2212x1659px — 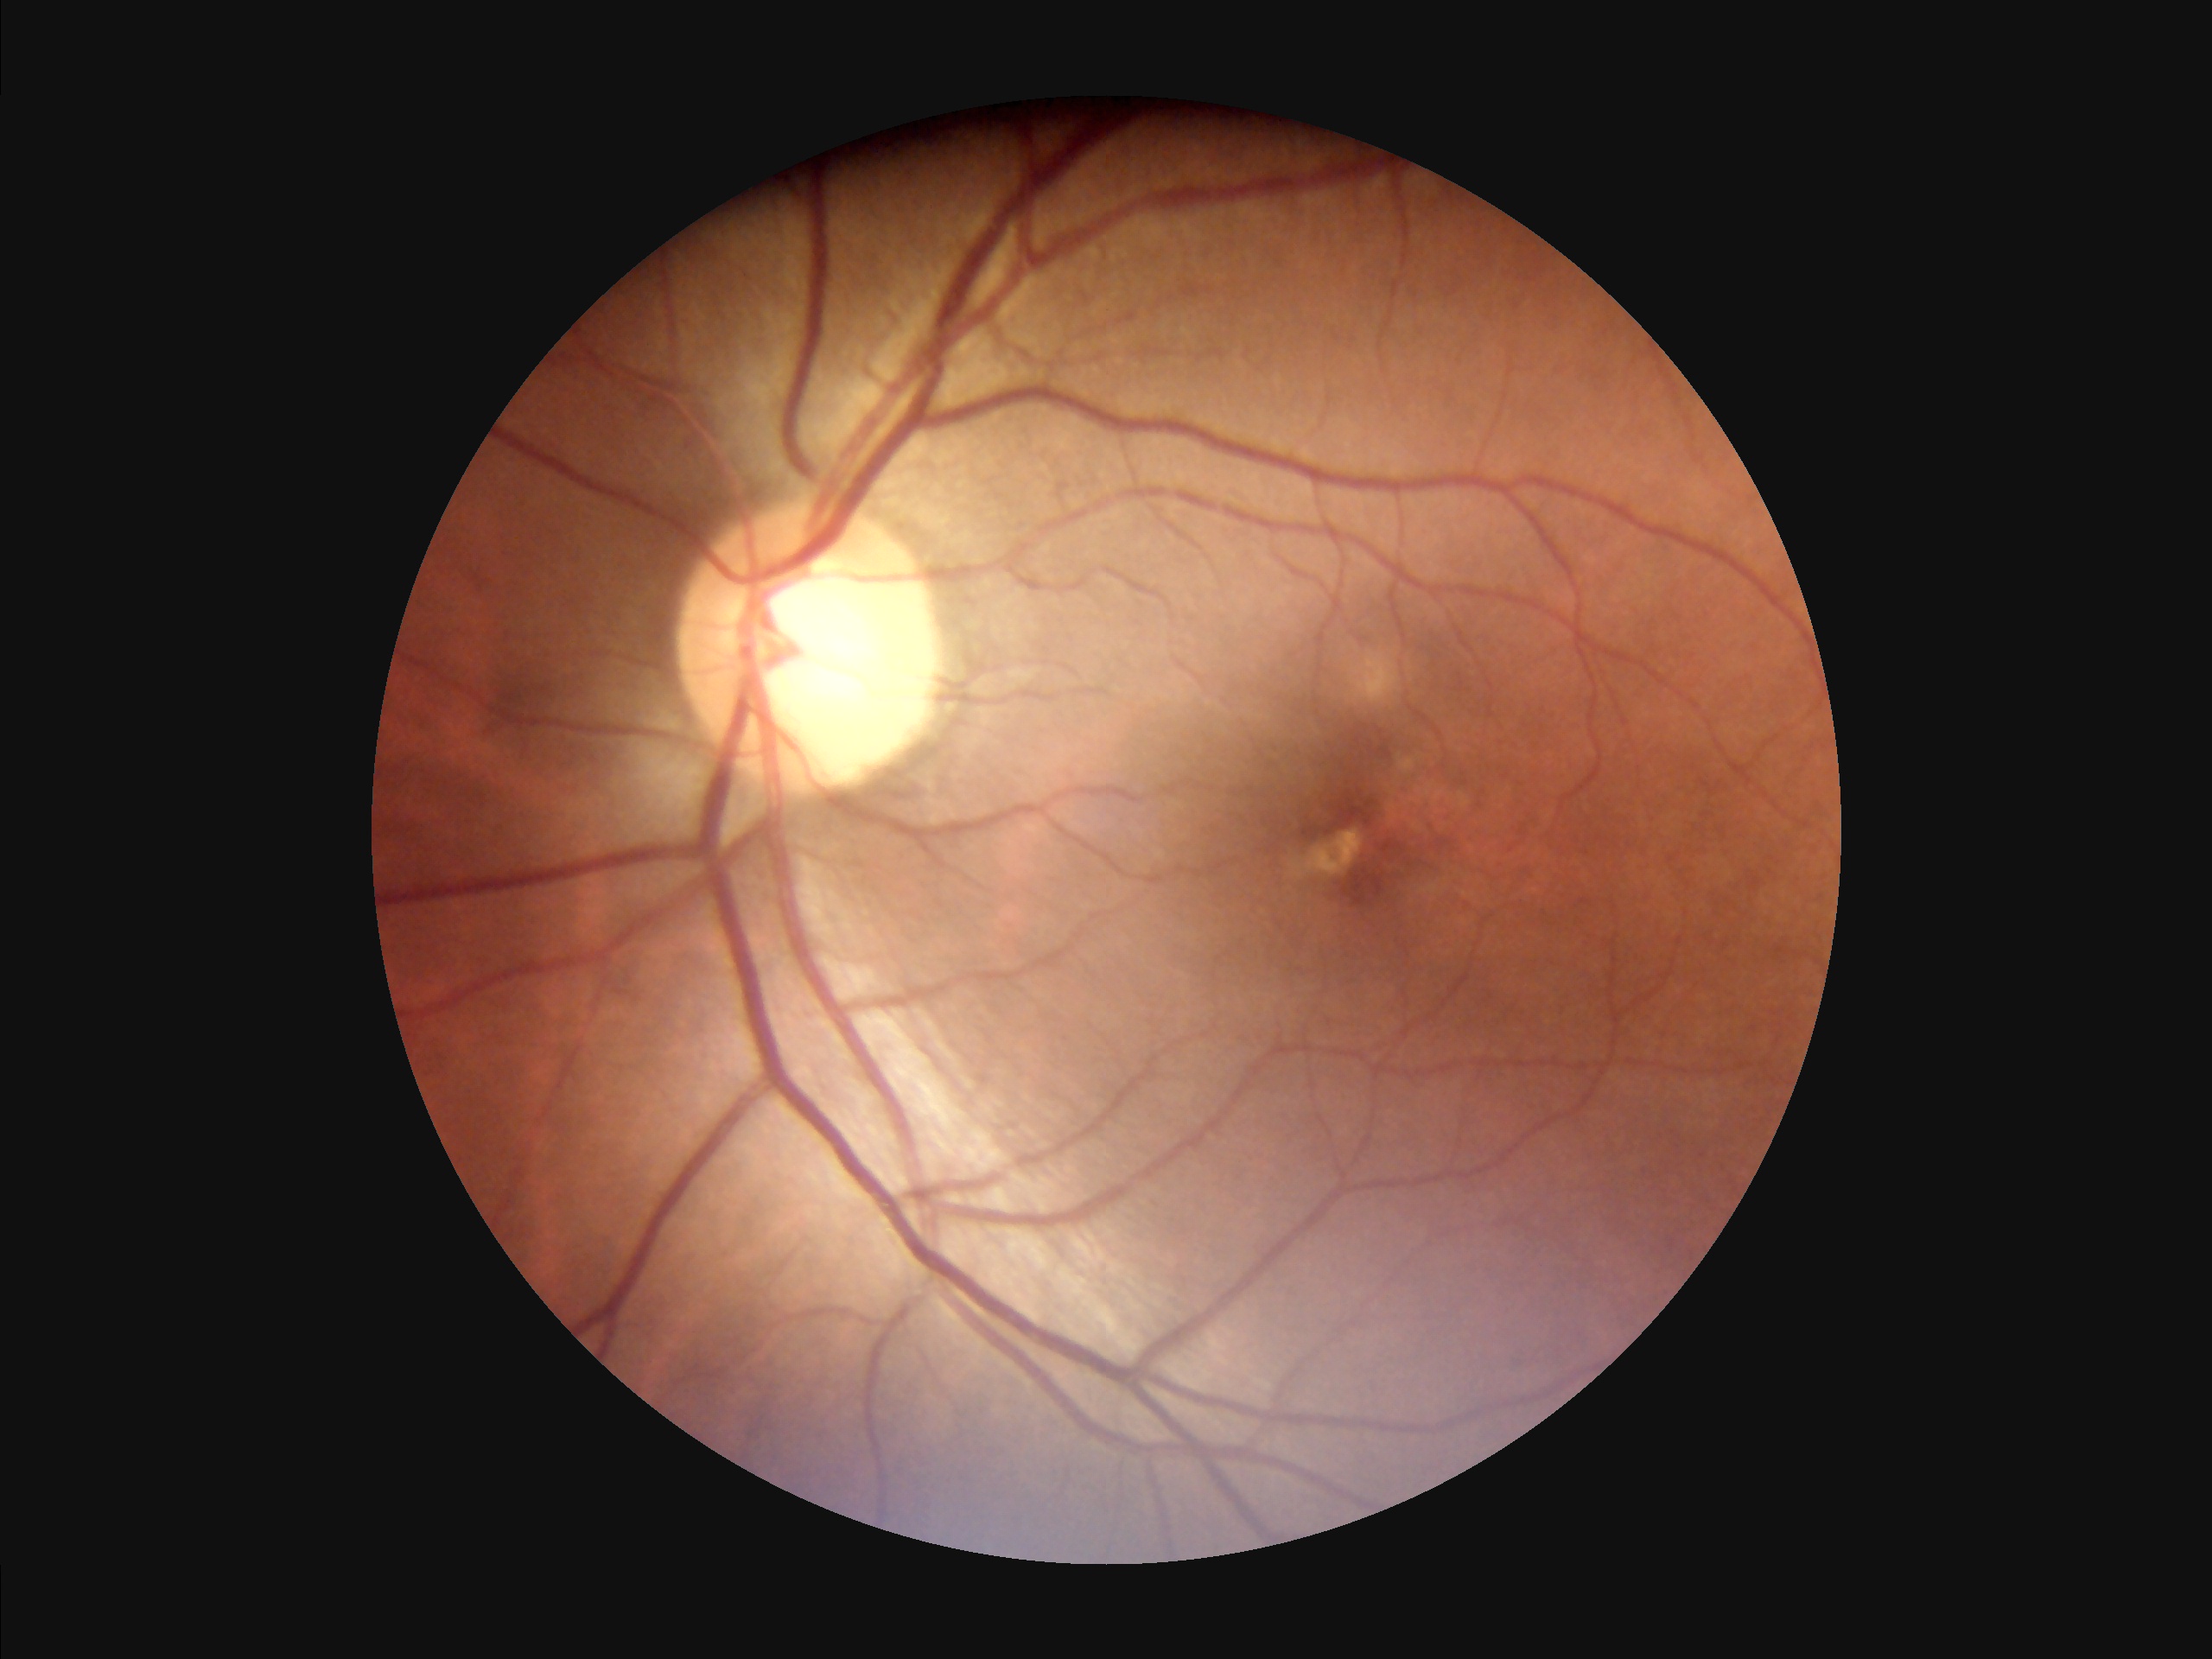 Overall quality is good and the image is gradable. Illumination and color are suboptimal. Adequate contrast for distinguishing structures. Optic disc, vessels, and background are in focus.